Wide-field fundus photograph of an infant · 640 by 480 pixels.
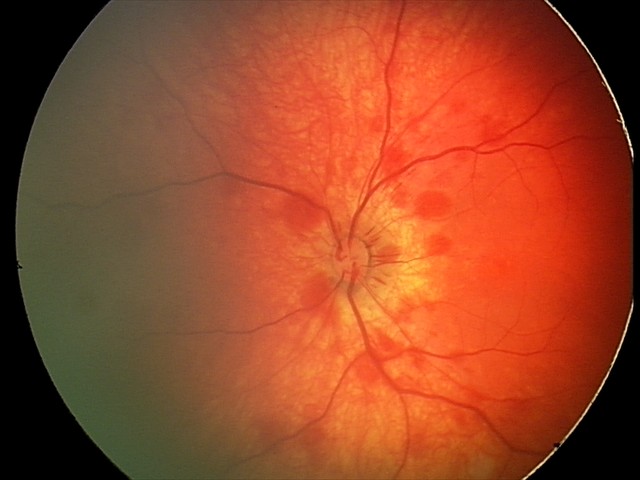
Examination diagnosed as retinal hemorrhages.